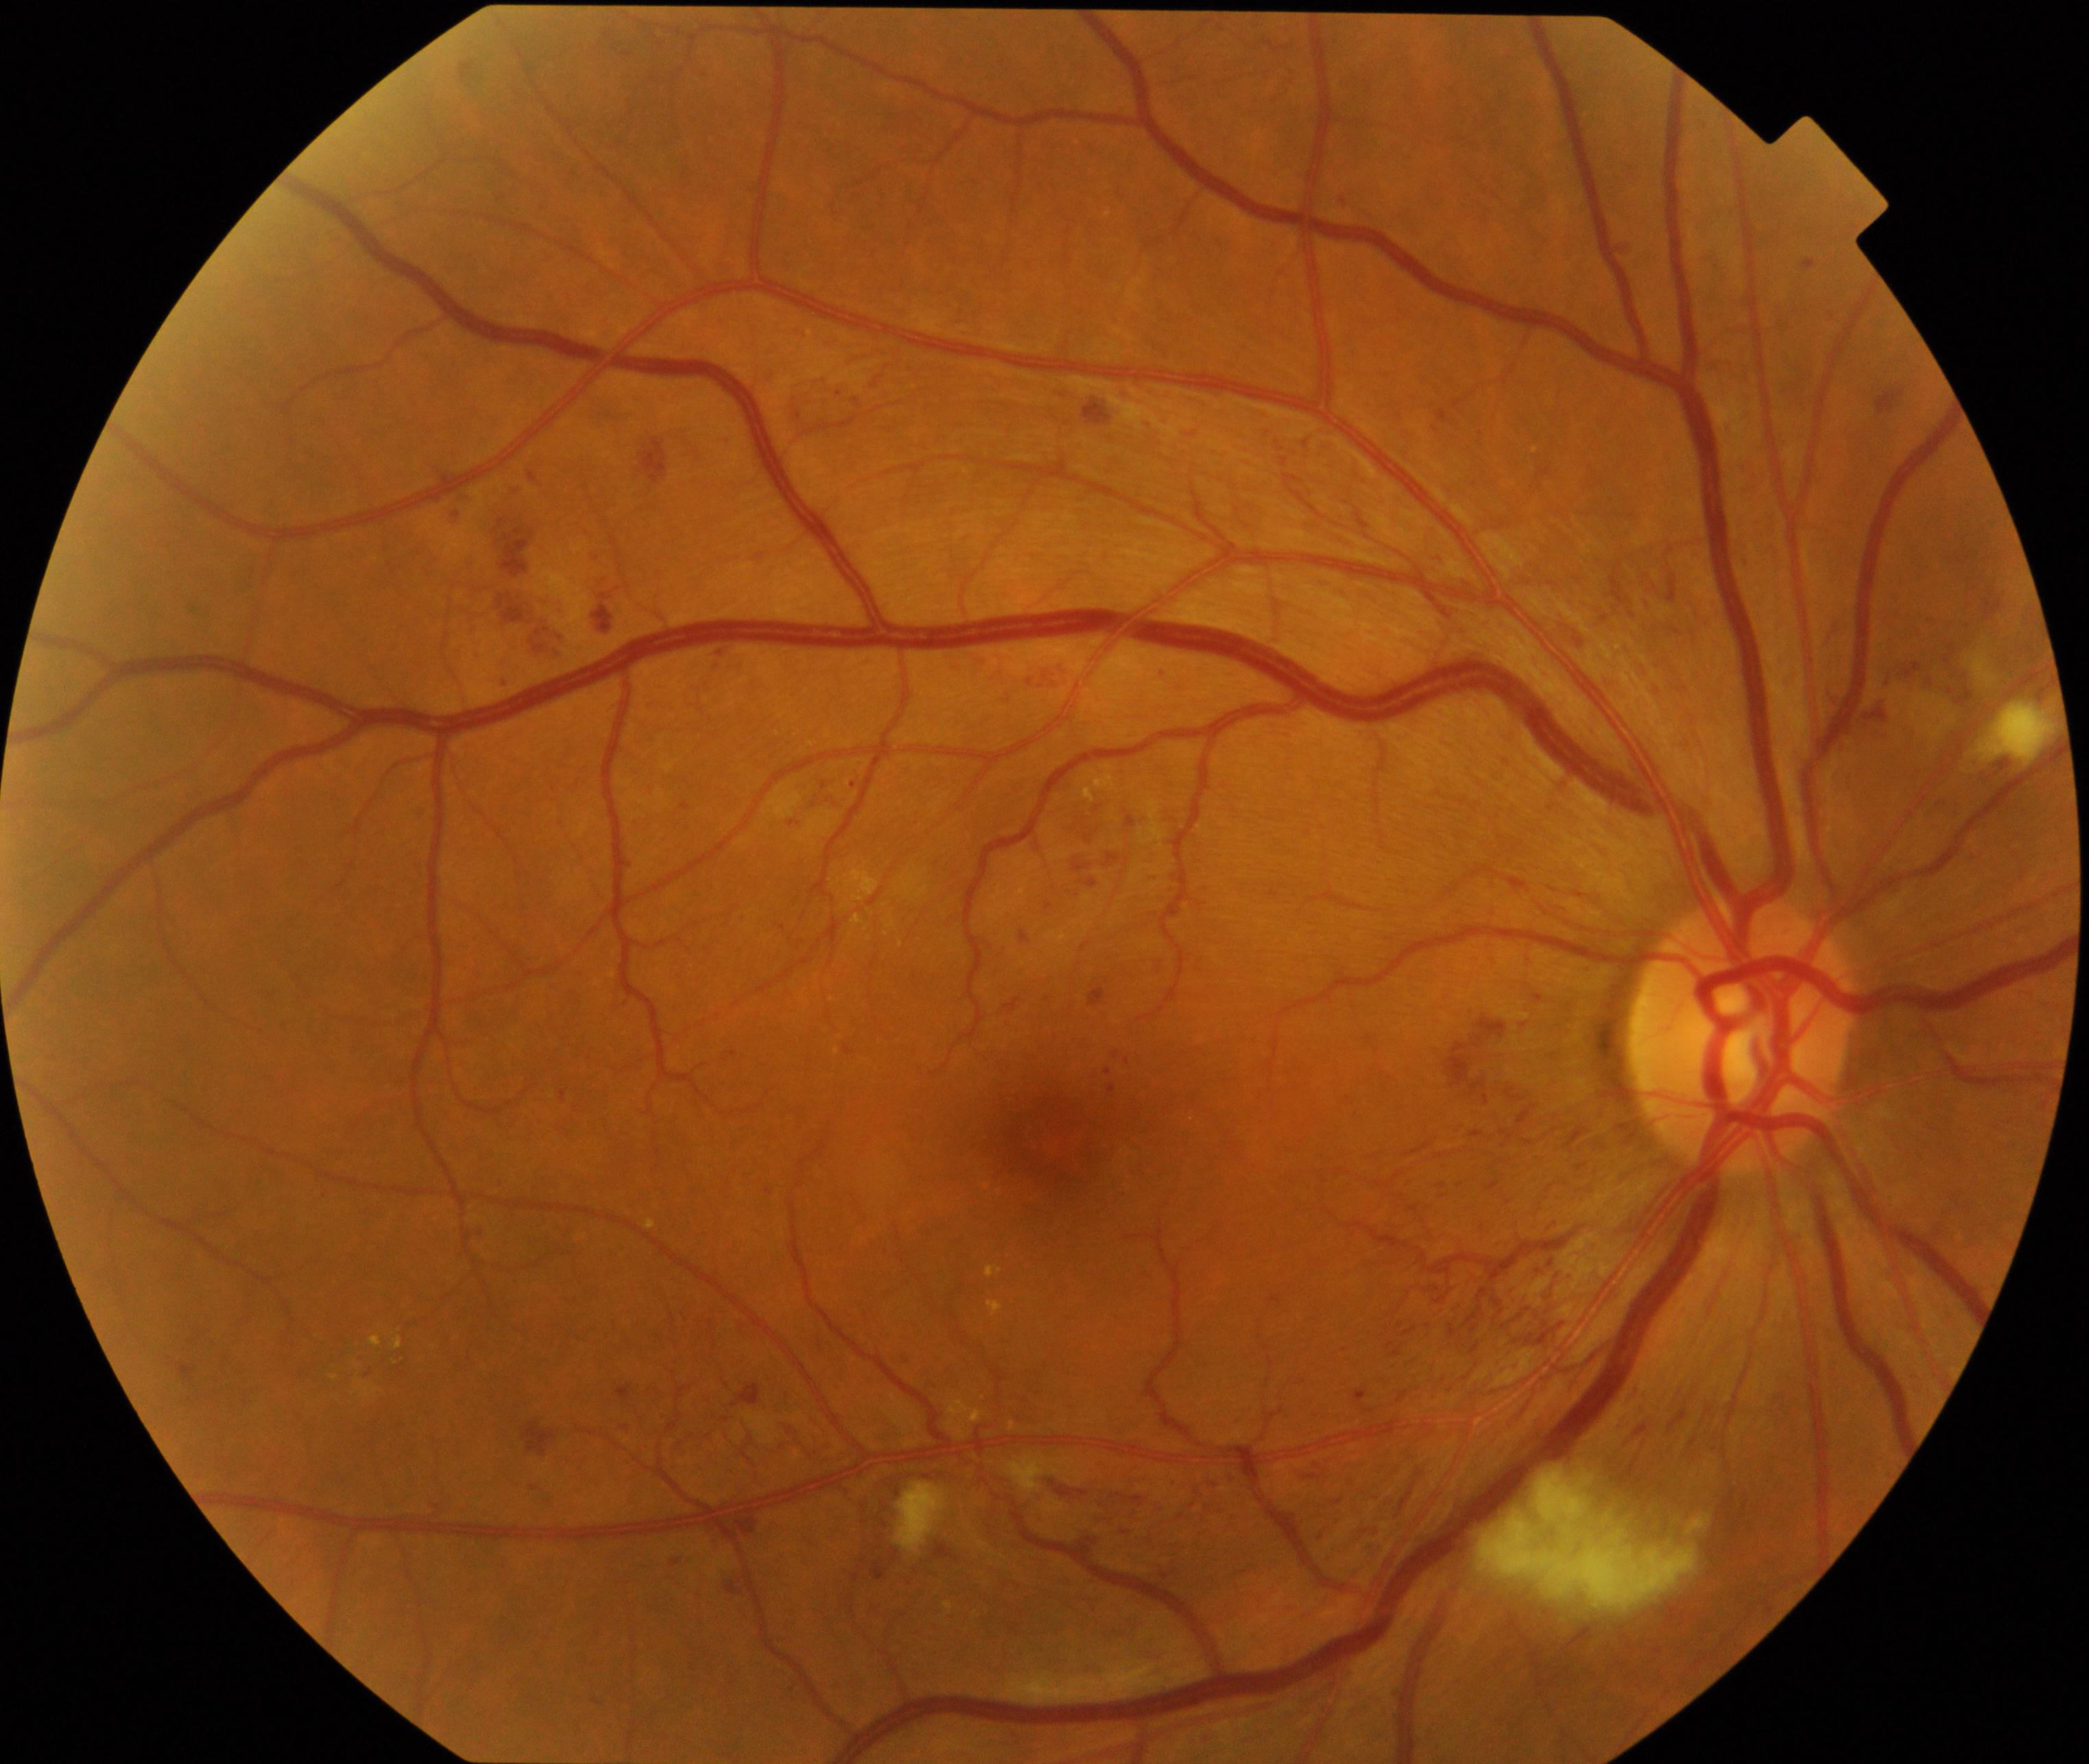 This fundus photograph shows moderate non-proliferative diabetic retinopathy.